Posterior pole photograph. 848 by 848 pixels. Davis DR grading
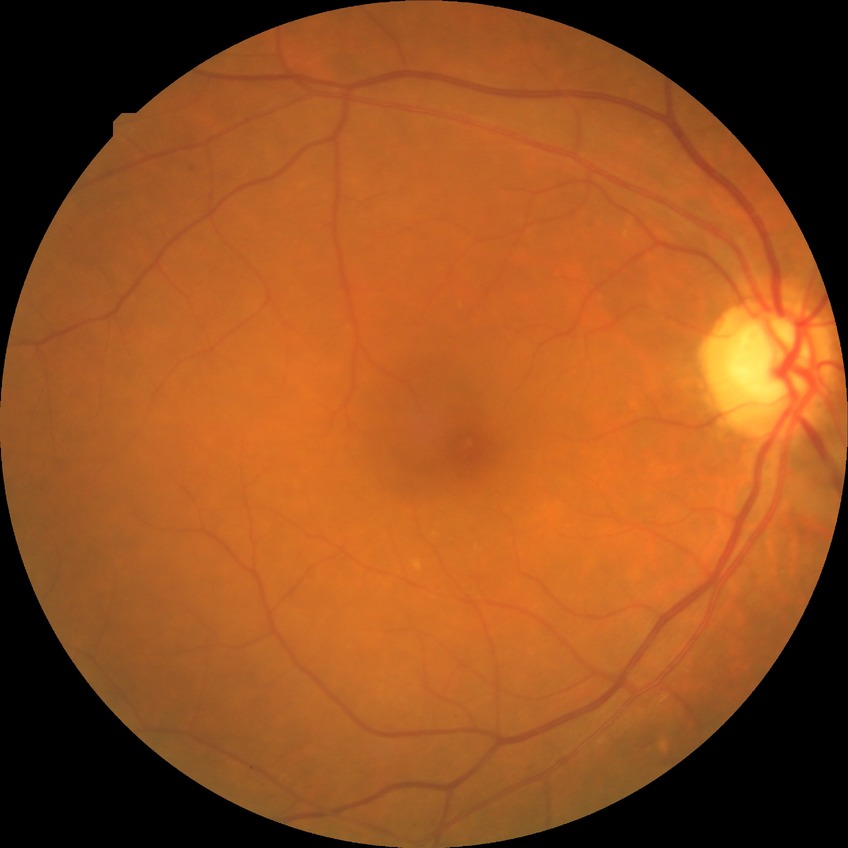 Davis grade: SDR.